Acquired on the Phoenix ICON · 1240x1240px · infant wide-field retinal image — 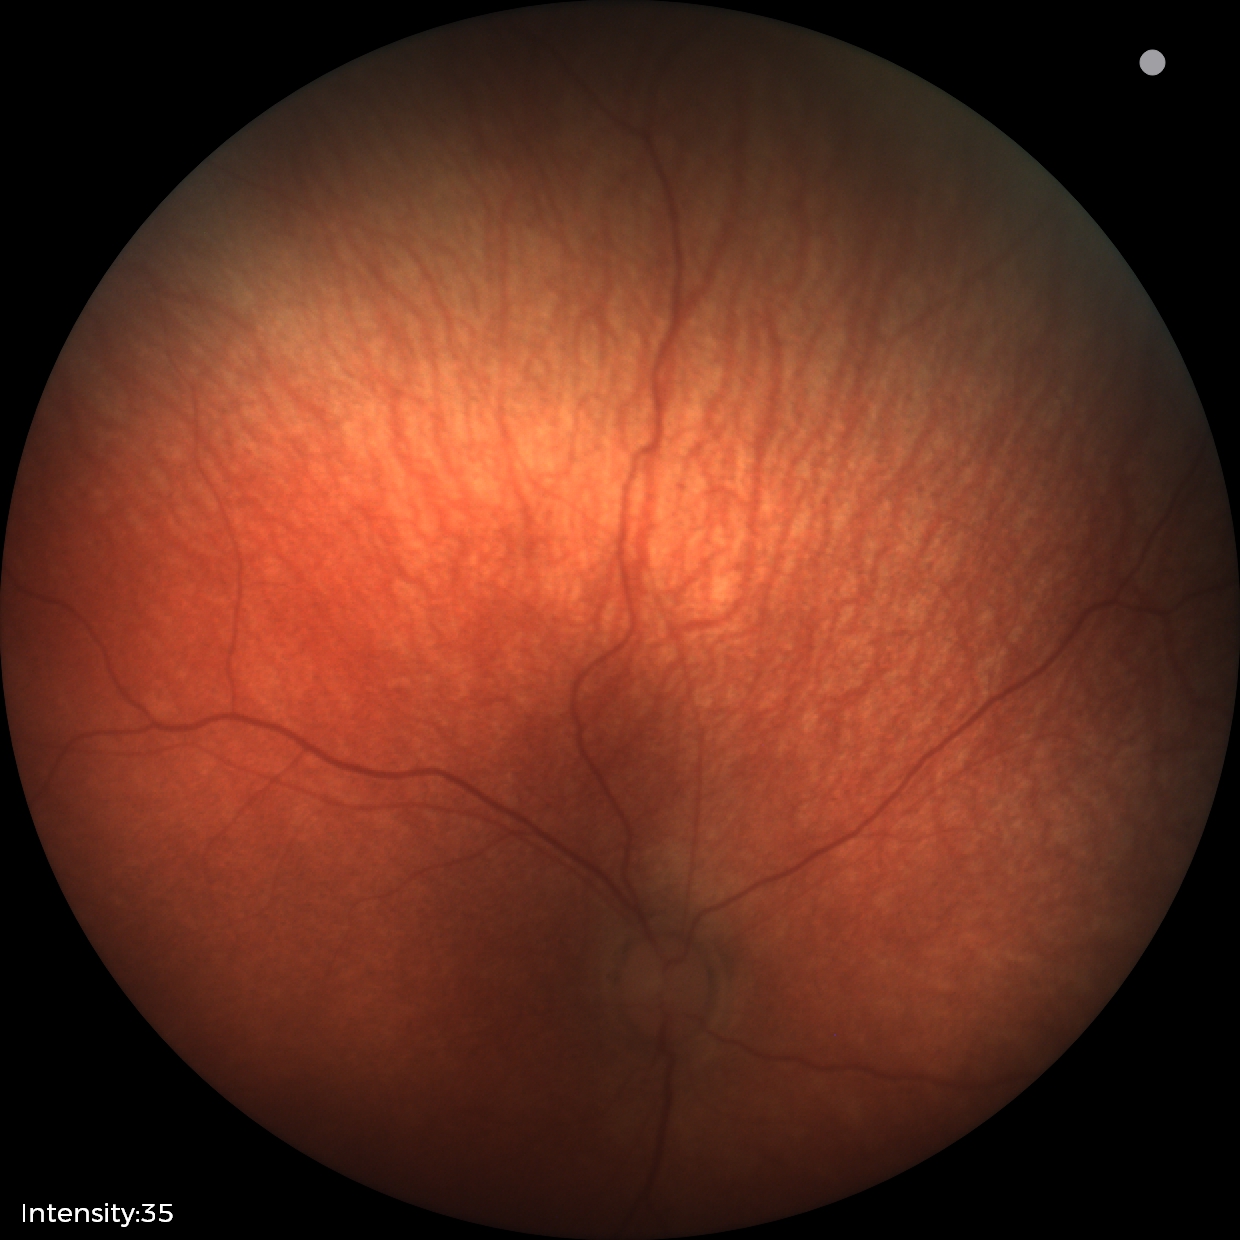 No retinal pathology identified on screening.